NIDEK AFC-230 · image size 848x848 · graded on the modified Davis scale · 45° field of view.
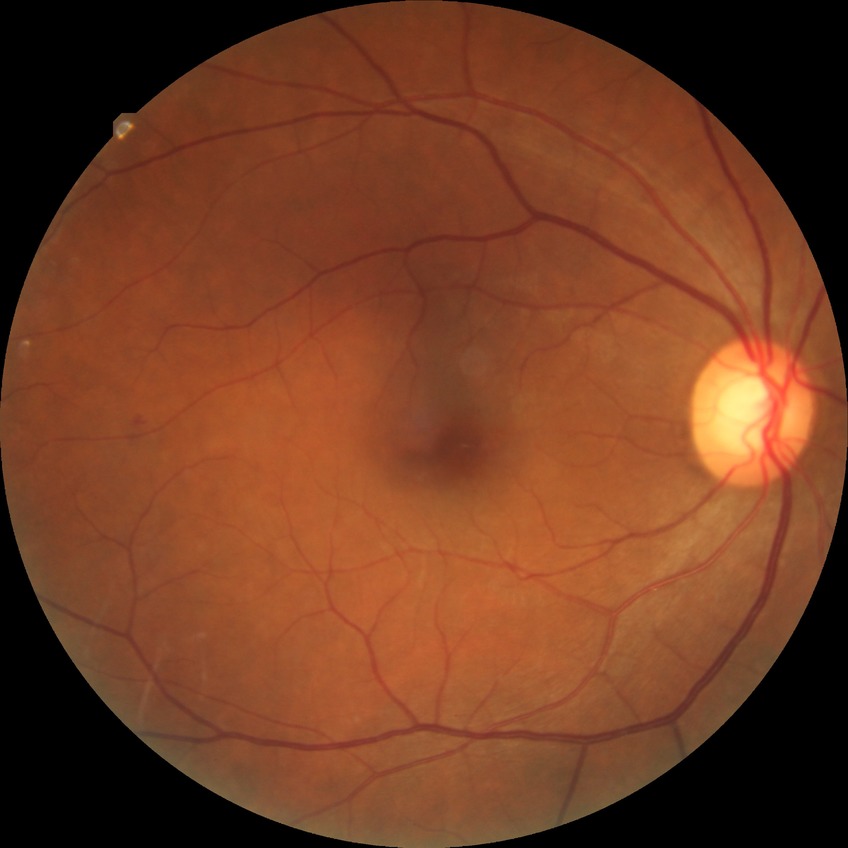
Diabetic retinopathy (DR): SDR (simple diabetic retinopathy). The retinopathy is classified as non-proliferative diabetic retinopathy.